RetCam wide-field infant fundus image — 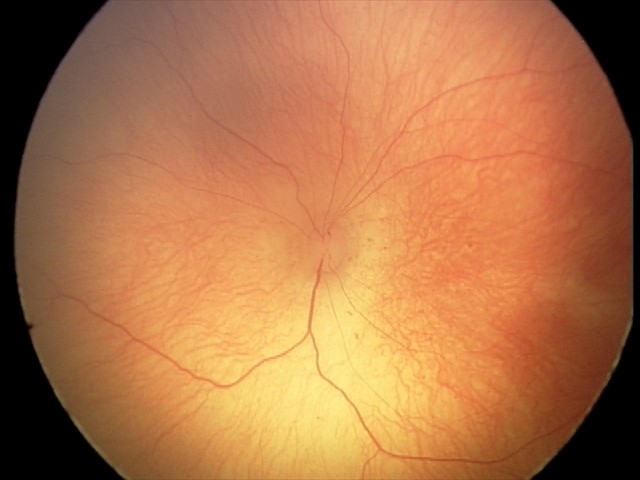
Screening series with retinopathy of prematurity stage 0. Without plus disease.